Fundus photo, image size 1659x2212 — 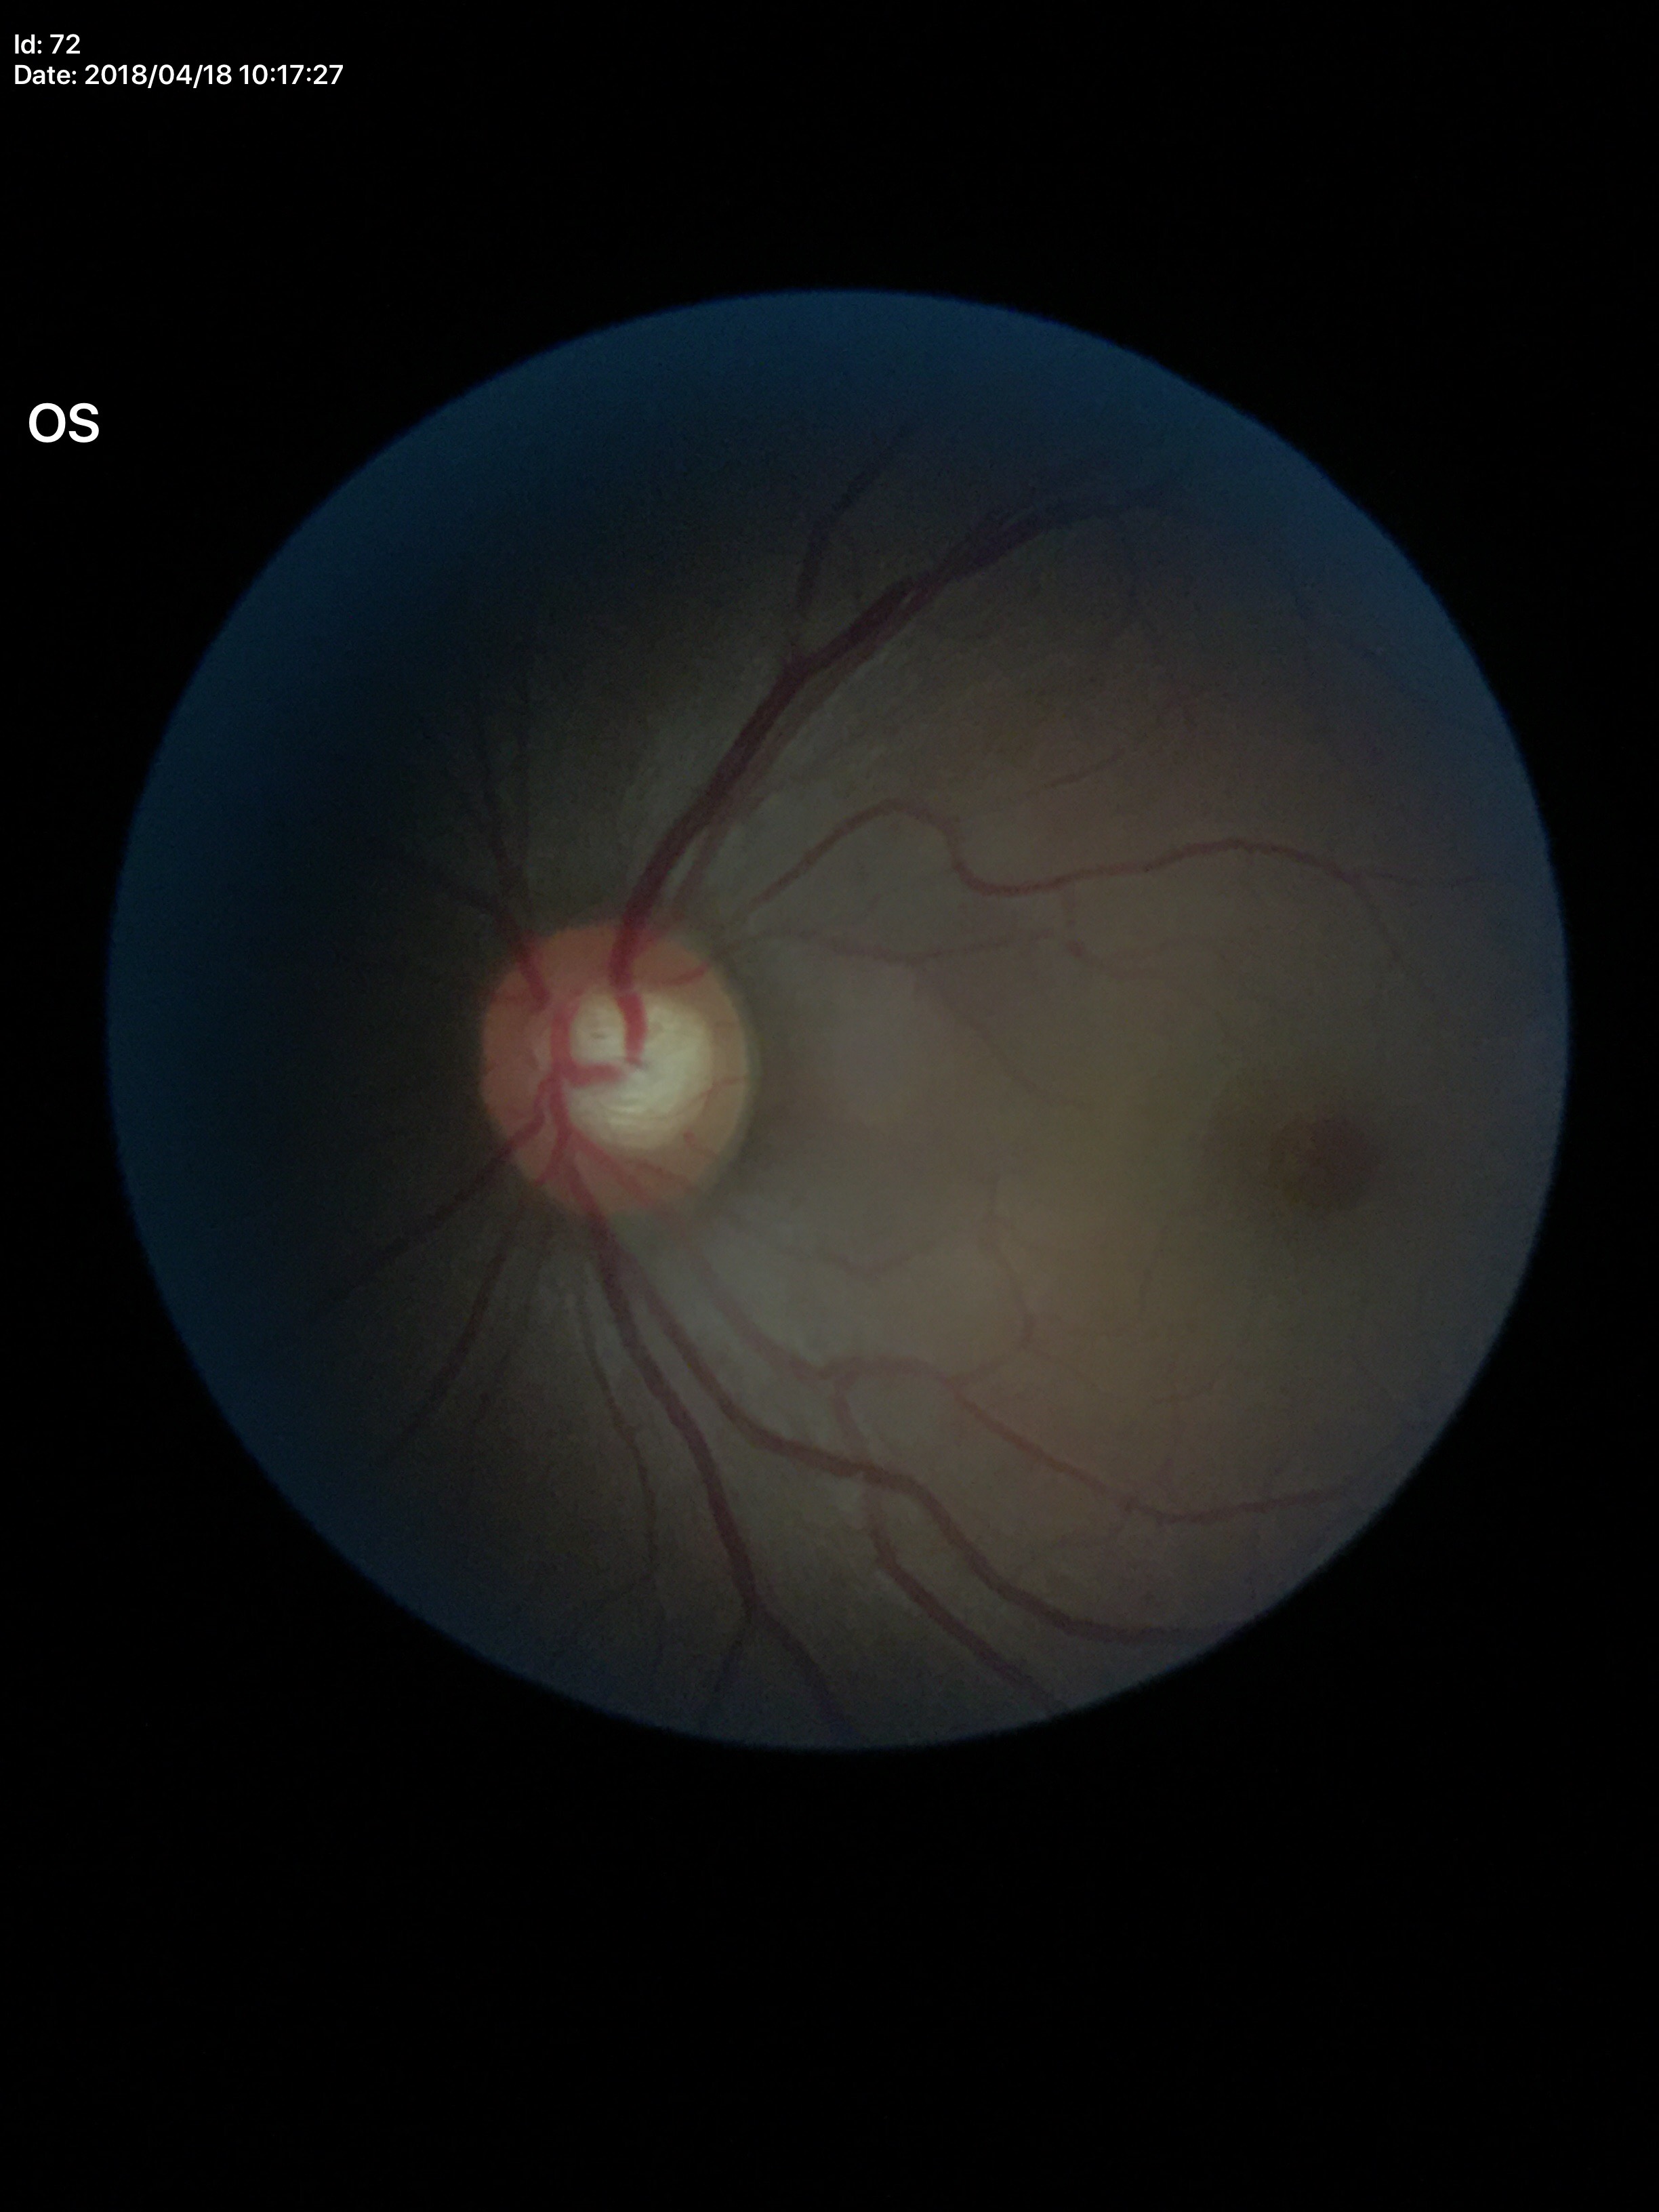
Glaucoma screening: no suspicious findings (all 5 graders called normal).
Vertical cup-disc ratio is 0.56.
Horizontal cup-disc ratio: 0.64.
Area CDR of 0.36.